Color fundus image: 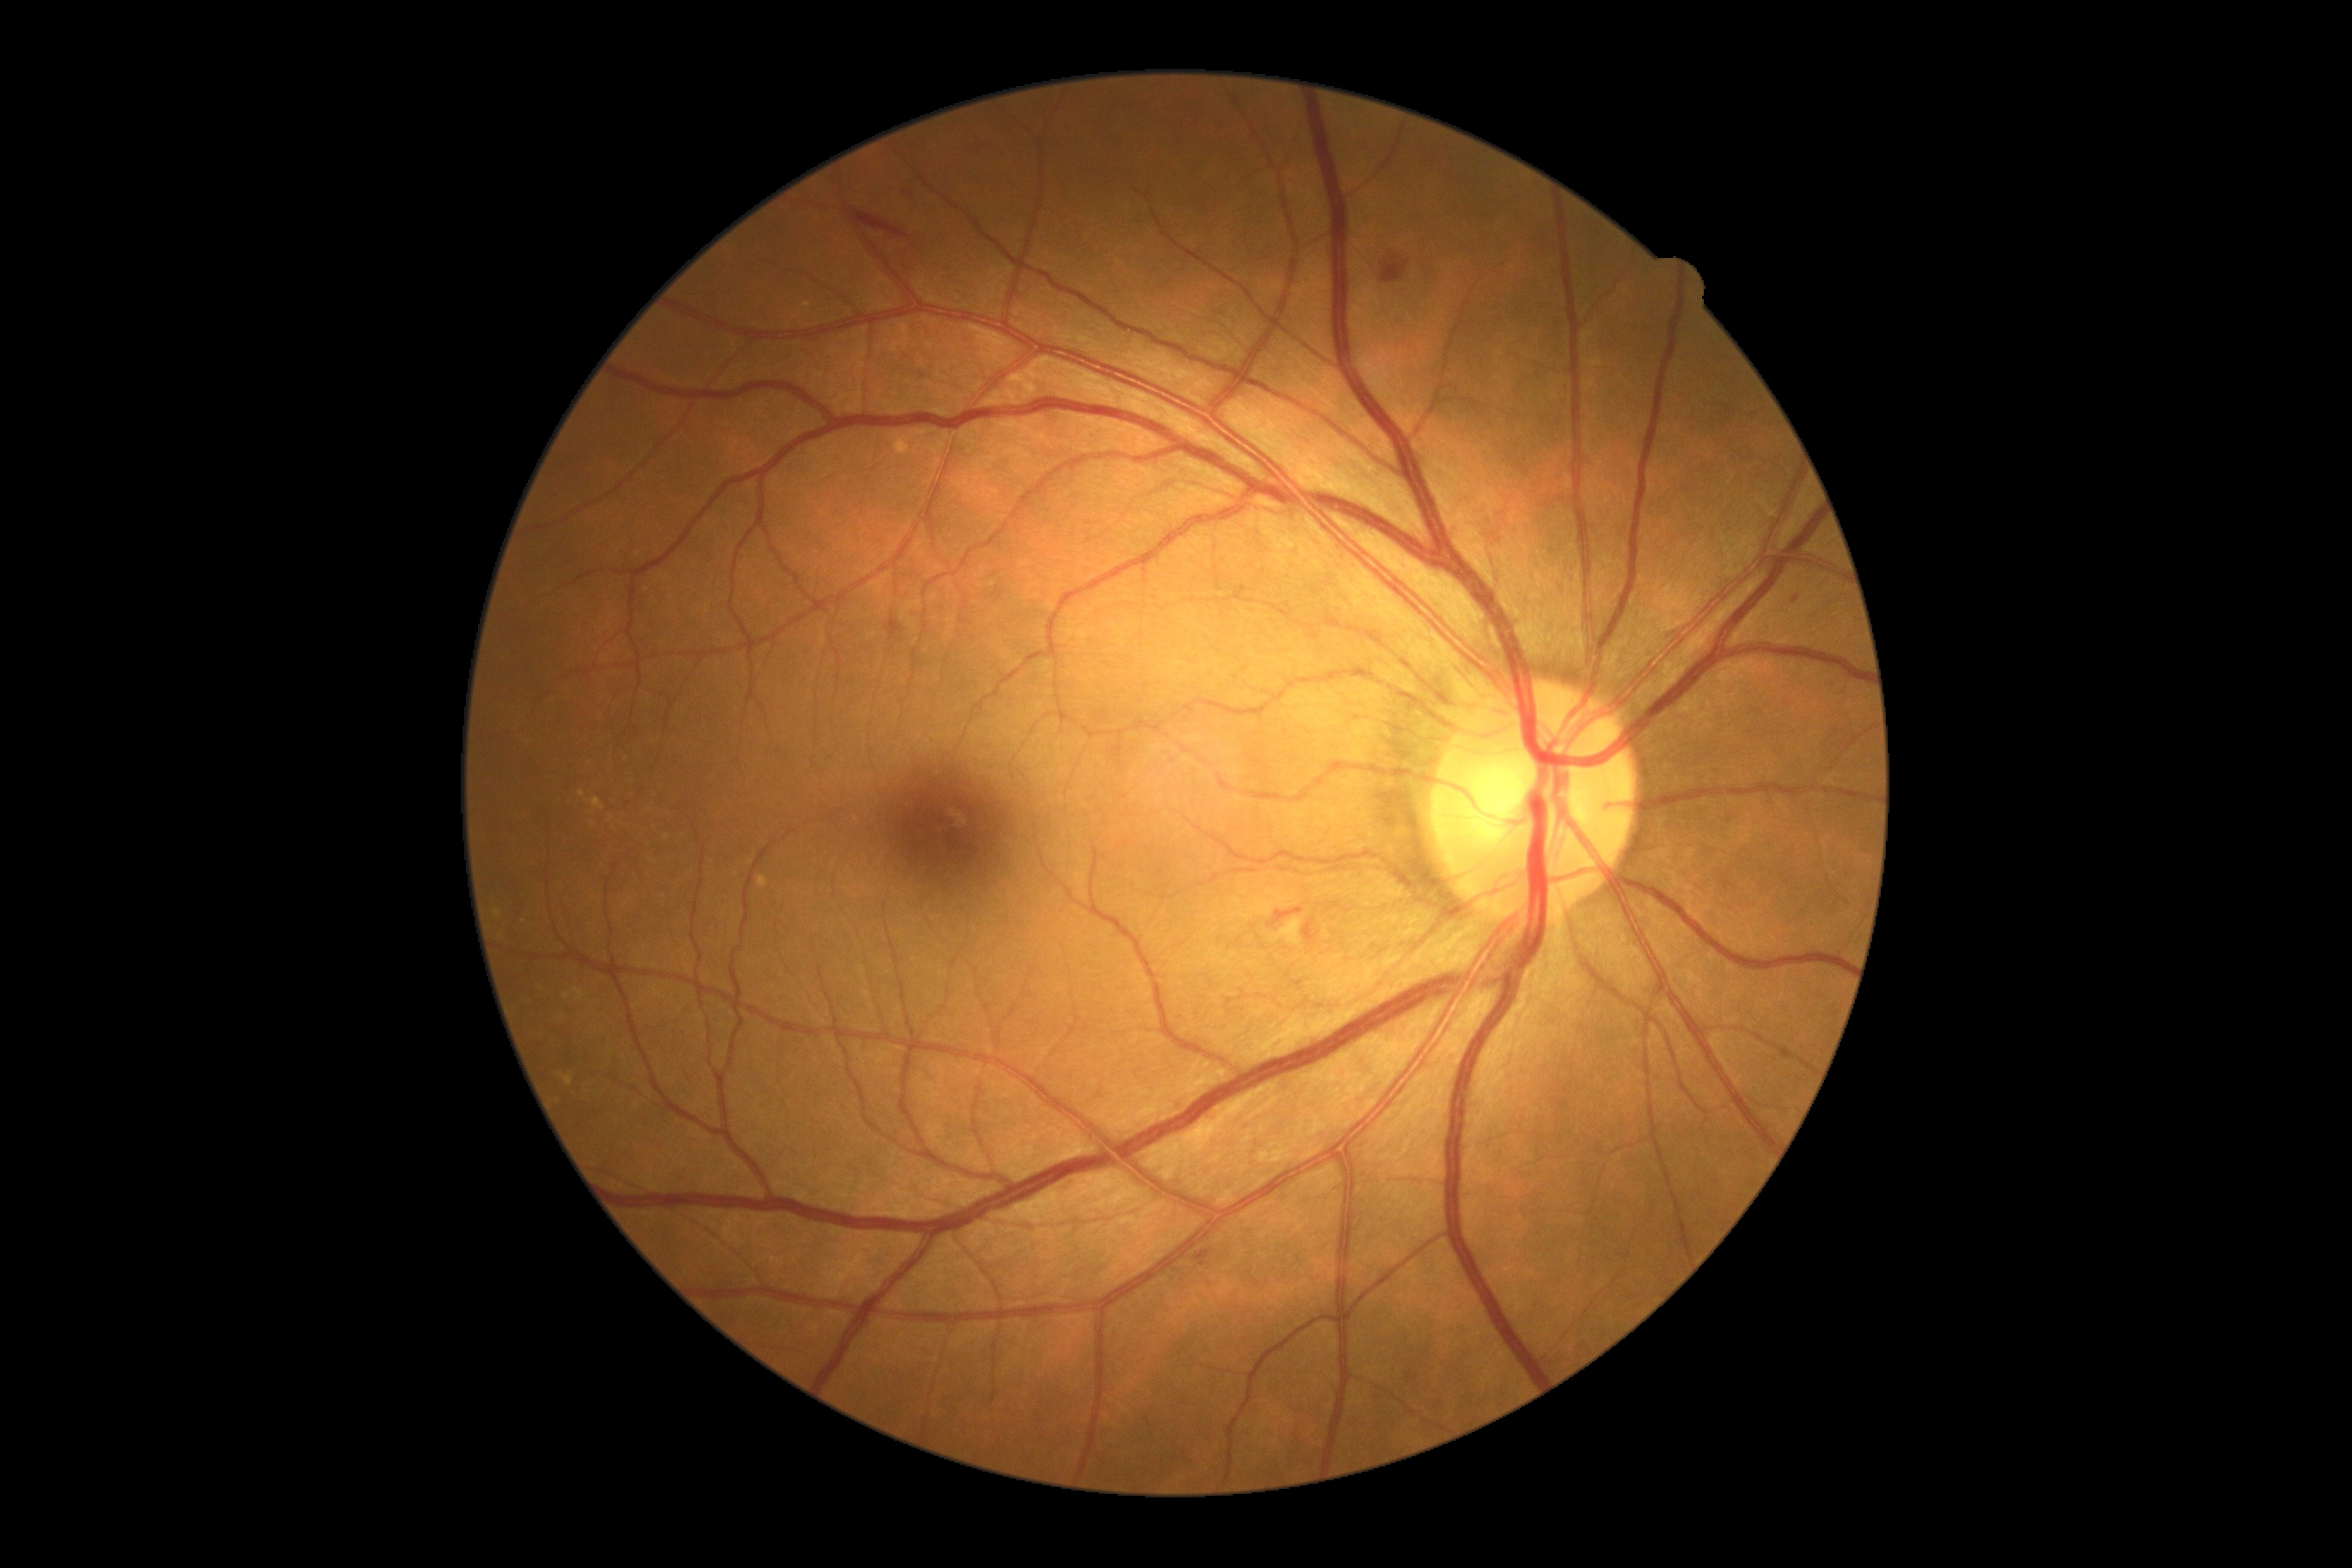

Retinopathy grade is moderate NPDR (2). Disease class: non-proliferative diabetic retinopathy.